RetCam wide-field infant fundus image. Natus RetCam Envision, 130° FOV:
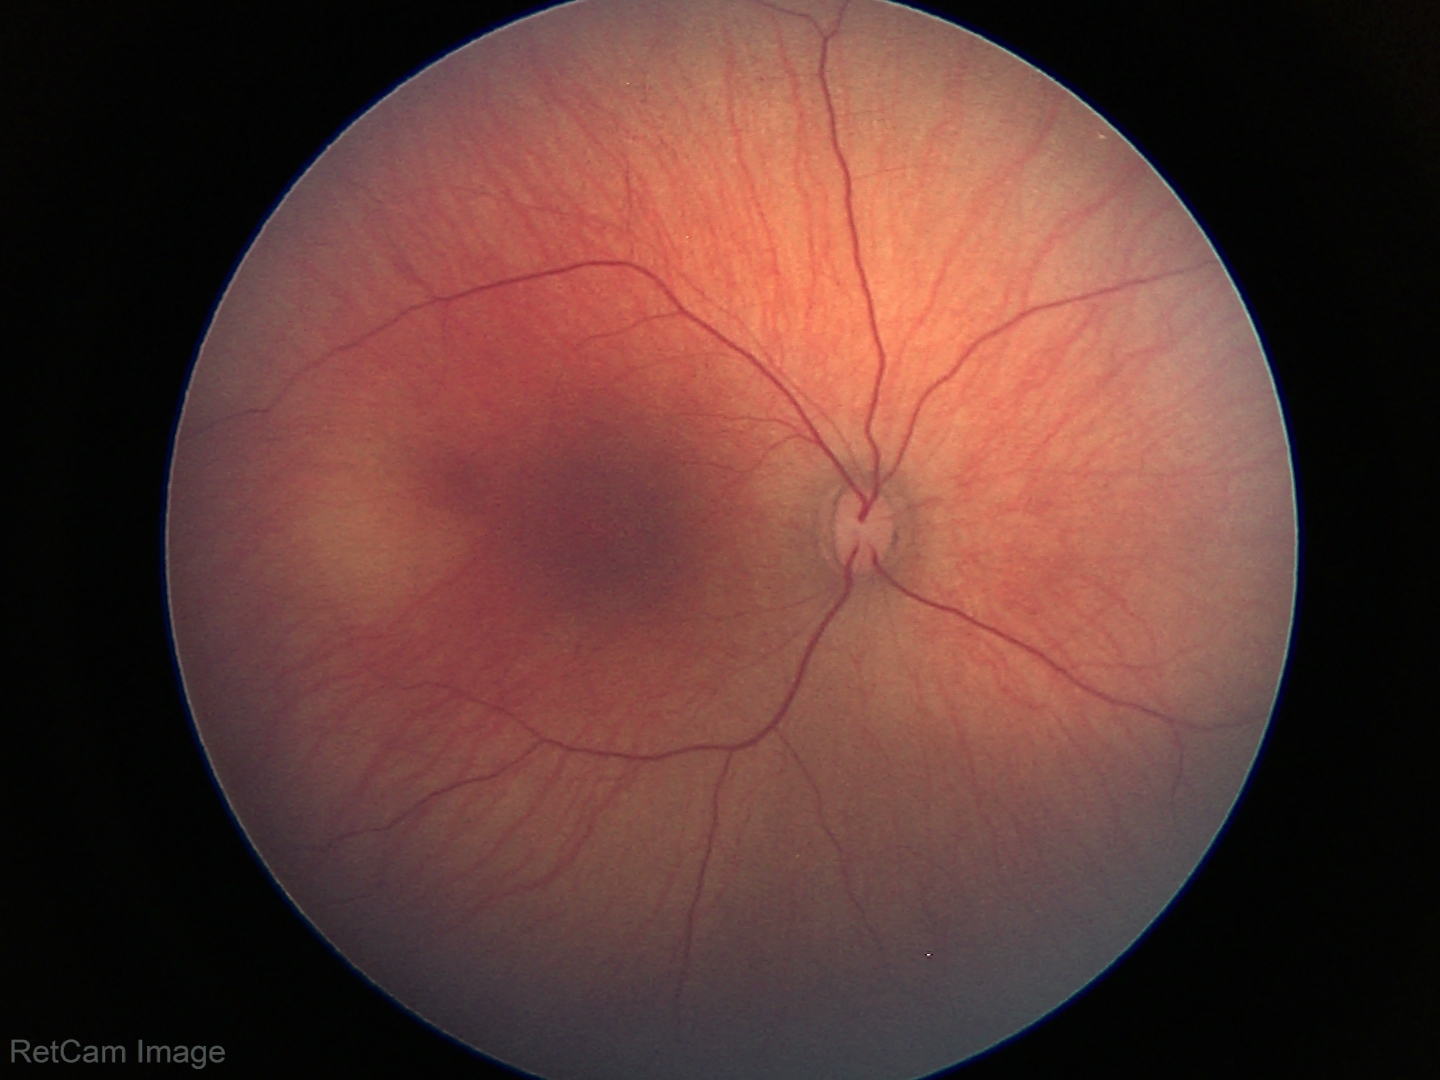

Normal screening examination.